Optic disc region of a color fundus photo
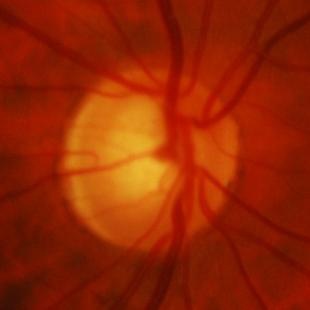
Q: What is the glaucoma diagnosis?
A: Yes — glaucomatous optic neuropathy.